Davis DR grading.
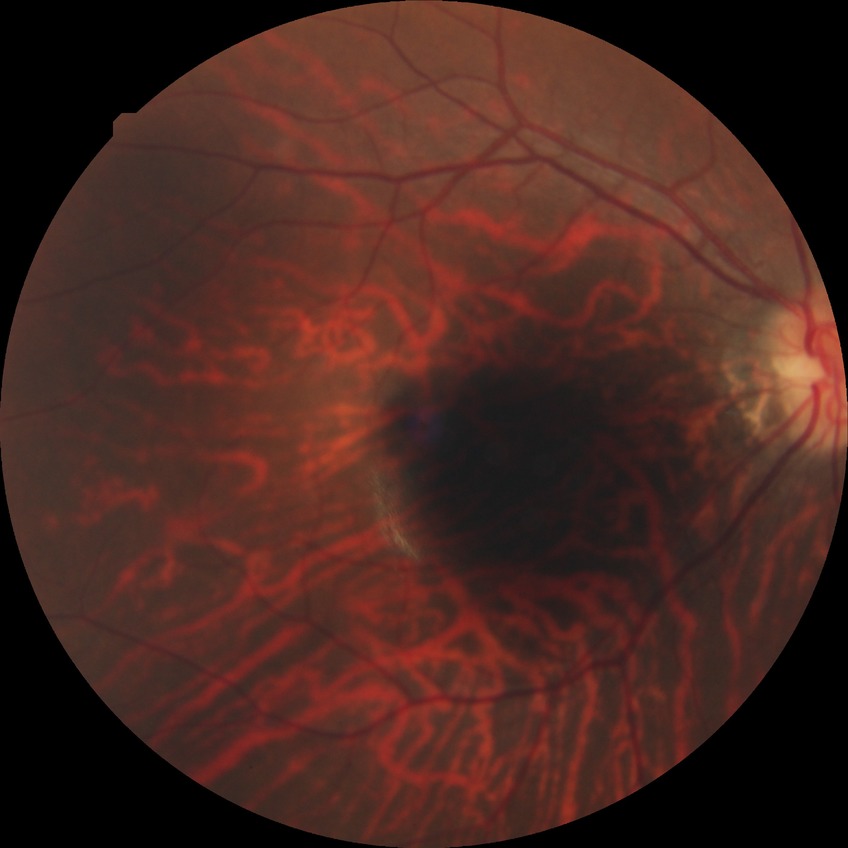
Modified Davis grading: no diabetic retinopathy.